Retinal fundus photograph. Captured on a Remidio smartphone fundus camera
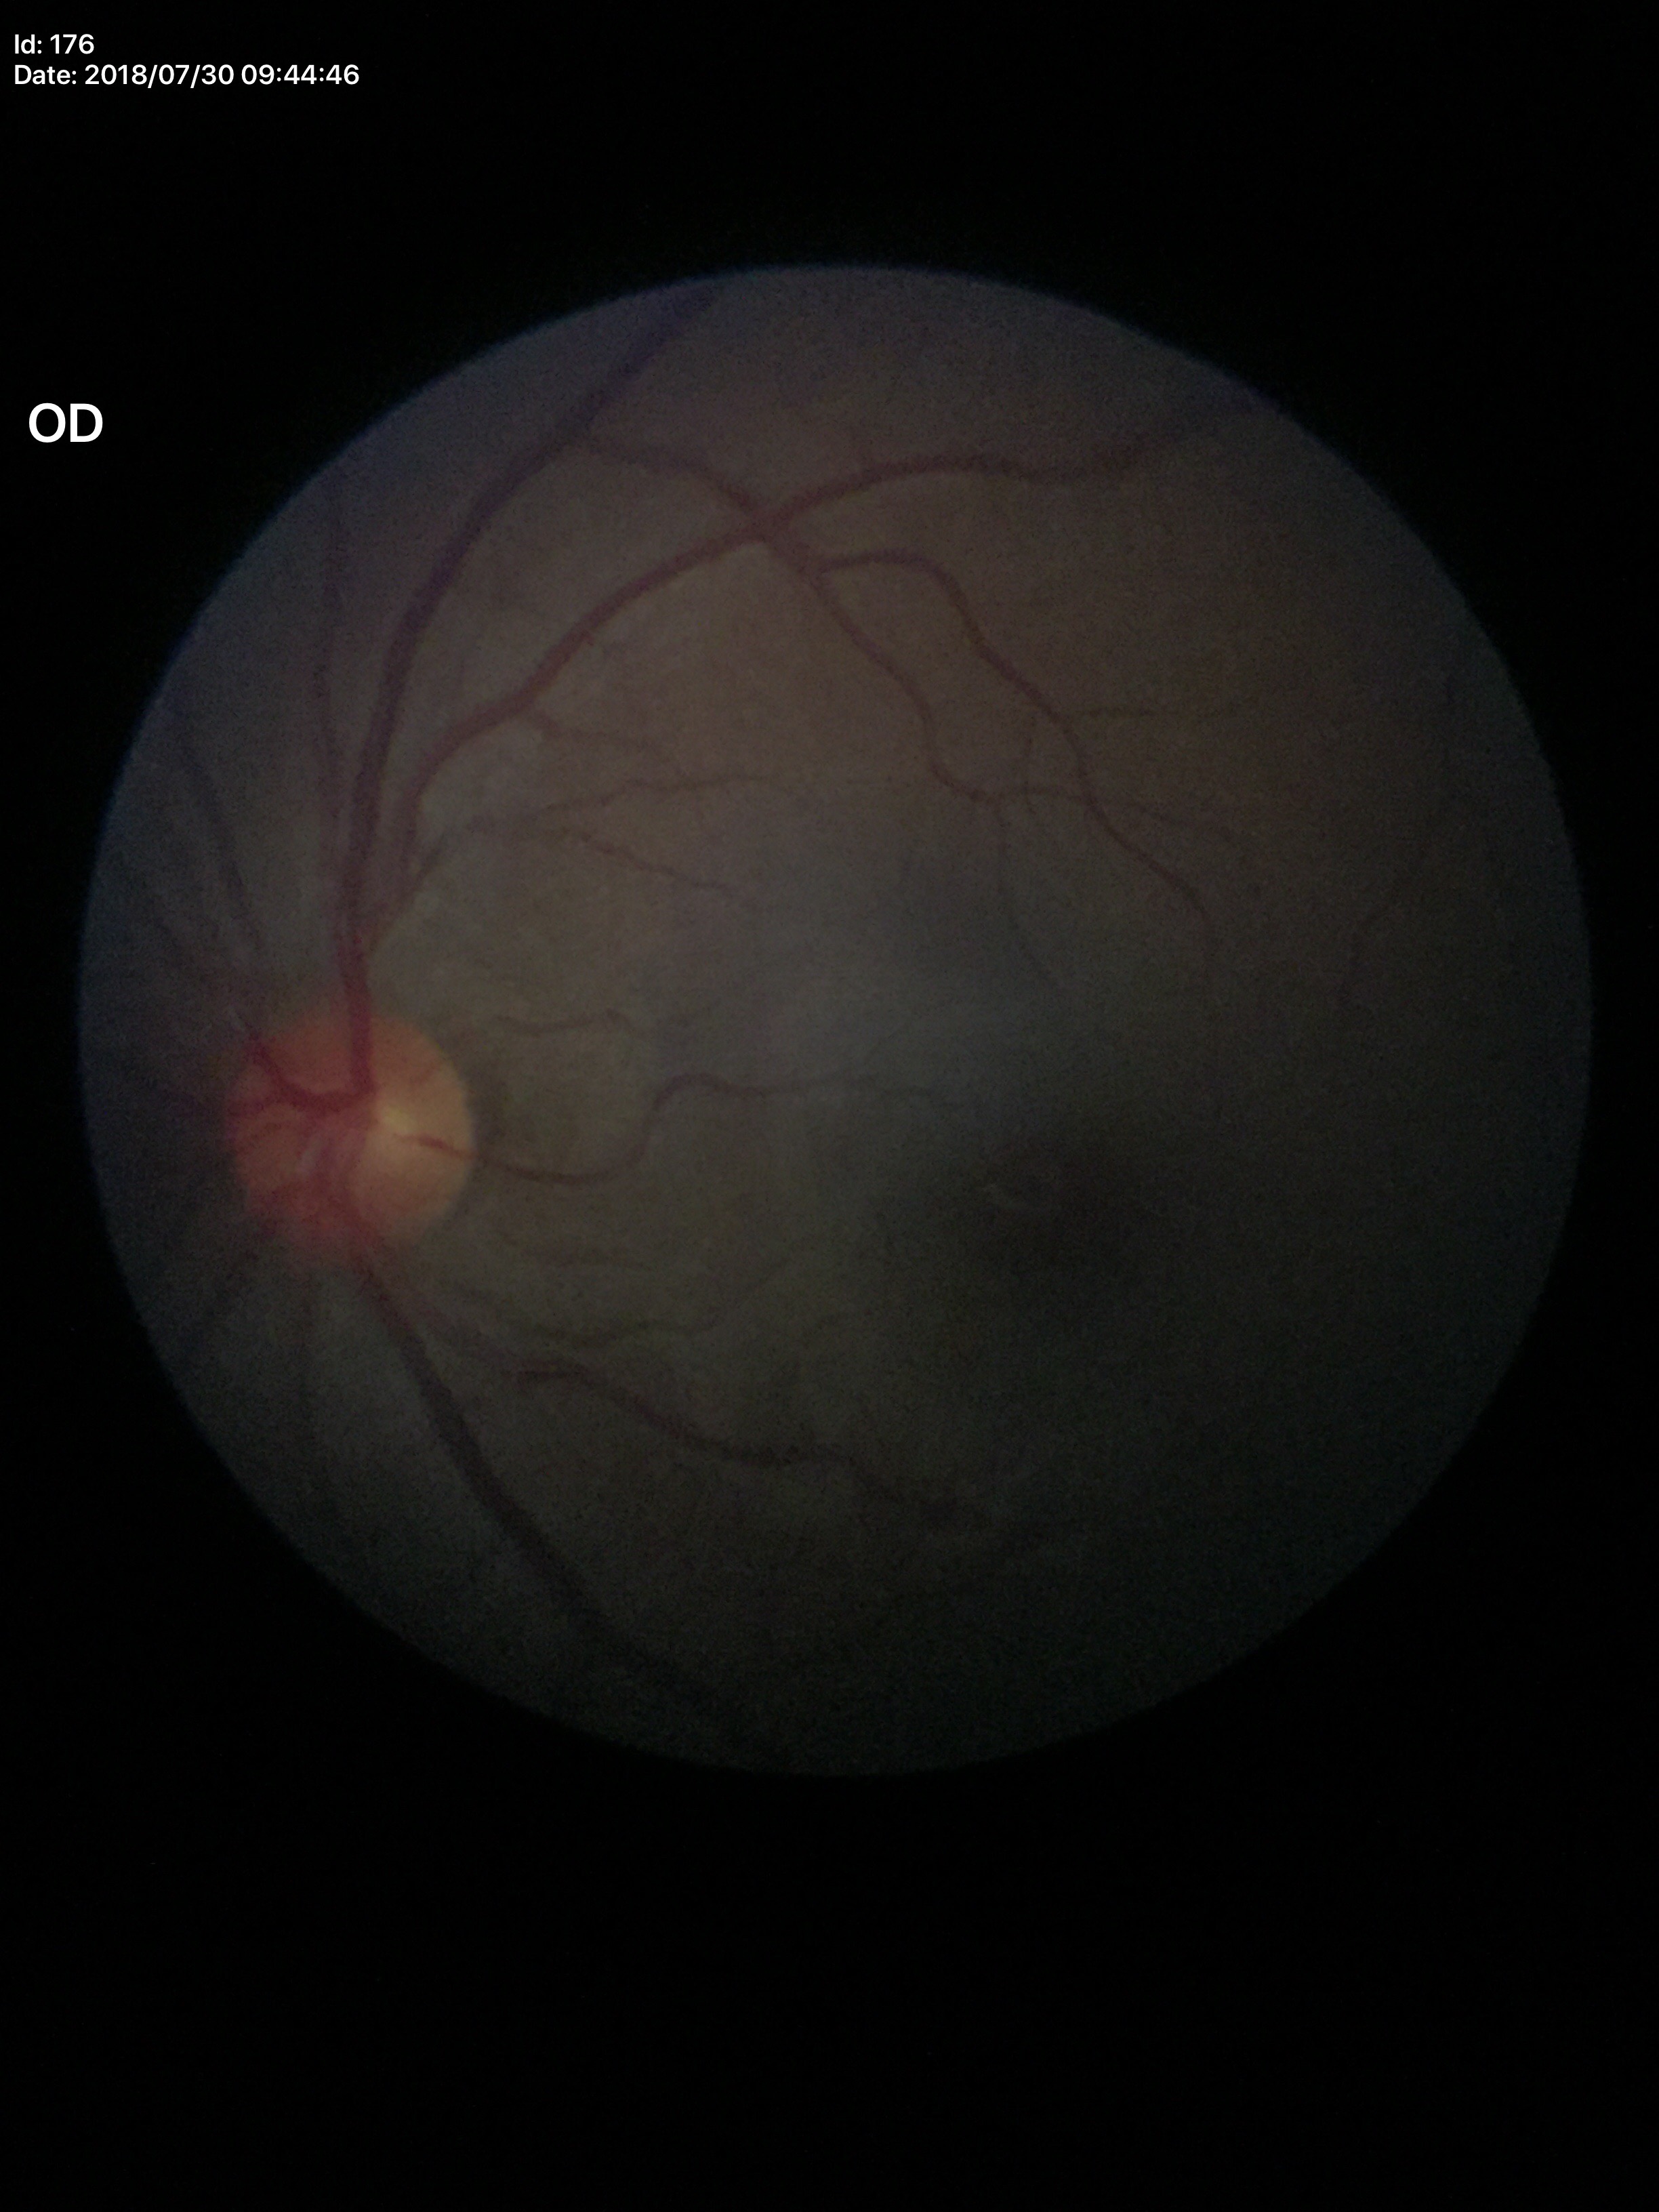

Glaucoma evaluation: not suspect. Vertical cup-disc ratio is 0.48.